1659 x 2212 pixels.
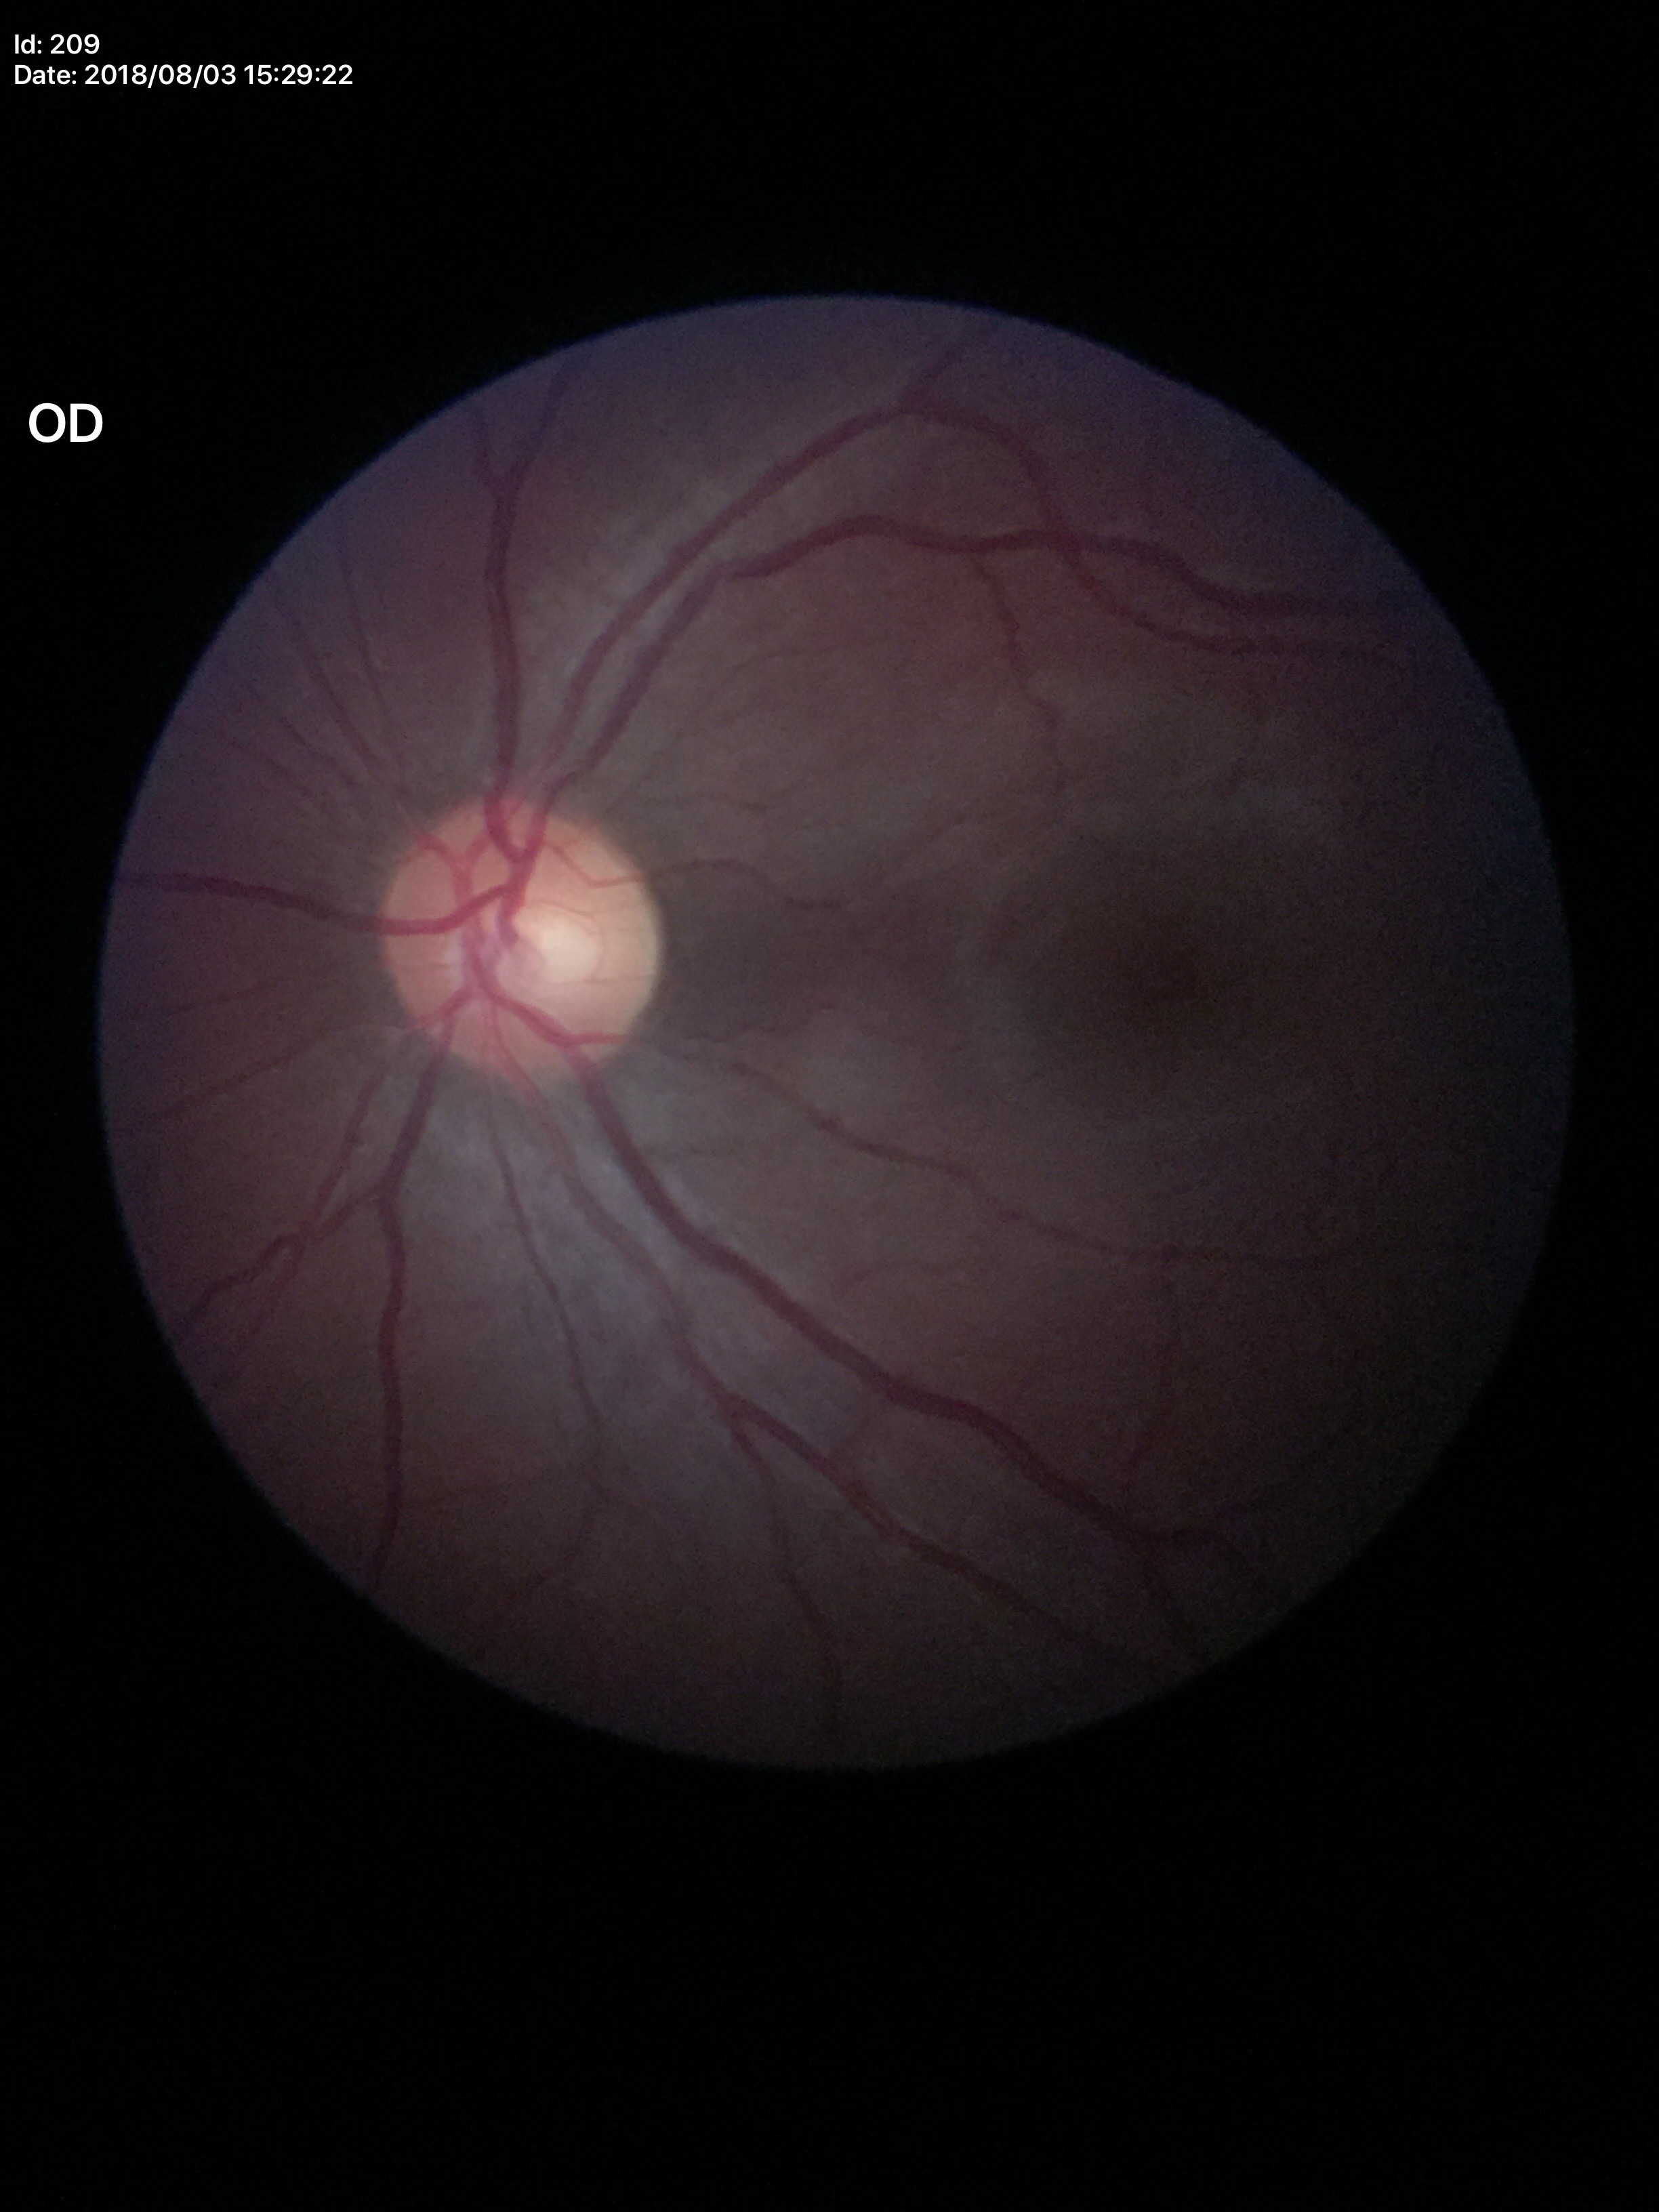

Not suspicious for glaucoma. Vertical cup-to-disc ratio: 0.49. Horizontal C/D ratio: 0.52.